45° field of view; camera: NIDEK AFC-230; without pupil dilation: 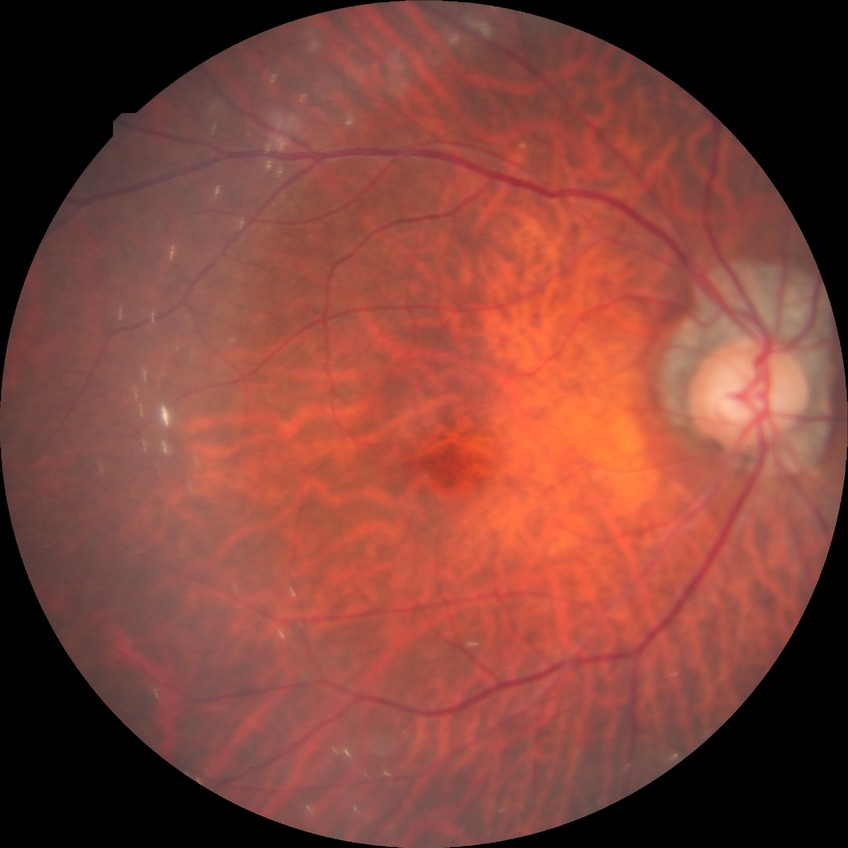 Annotations:
• retinopathy grade — no diabetic retinopathy